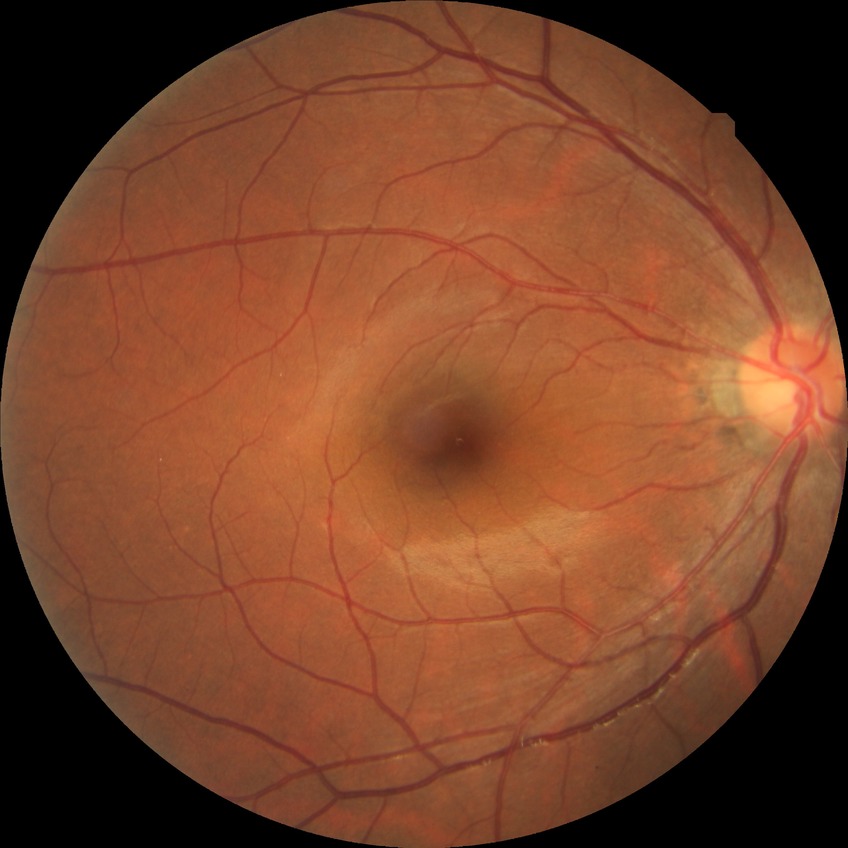
retinopathy grade: no diabetic retinopathy.